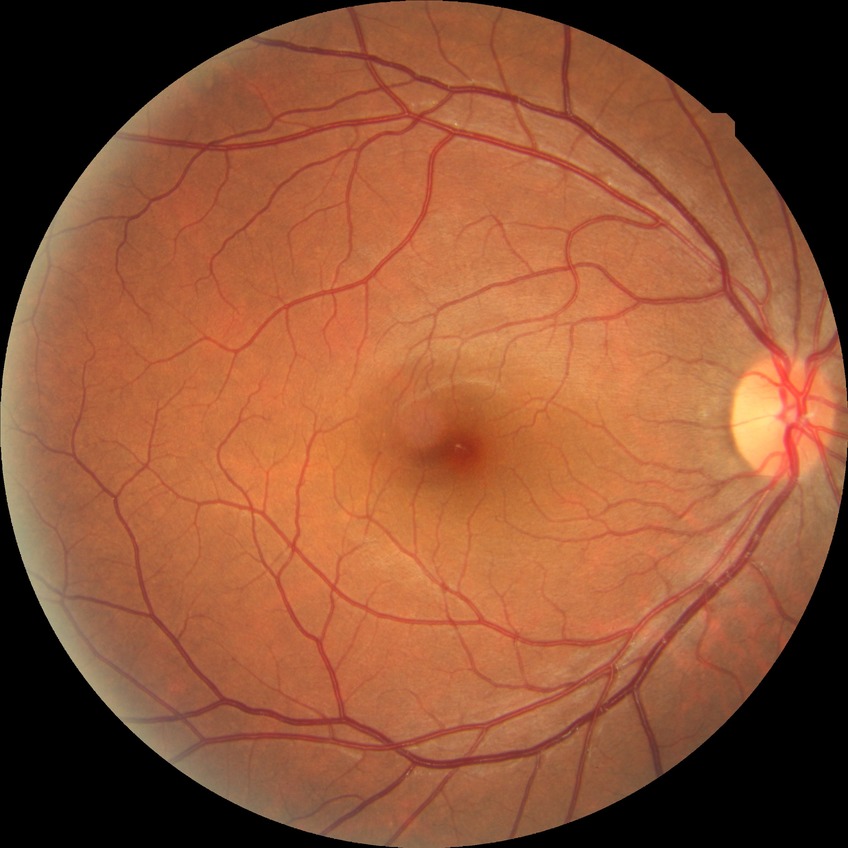   davis_grade: no diabetic retinopathy (NDR)